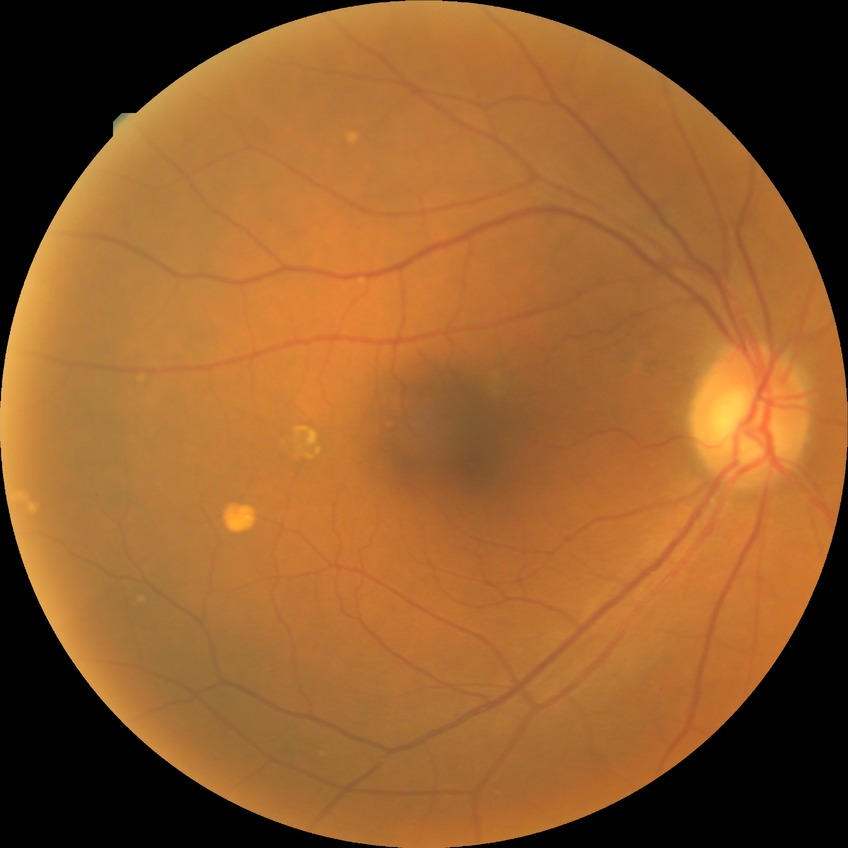
Davis stage: NDR.